2352x1568px.
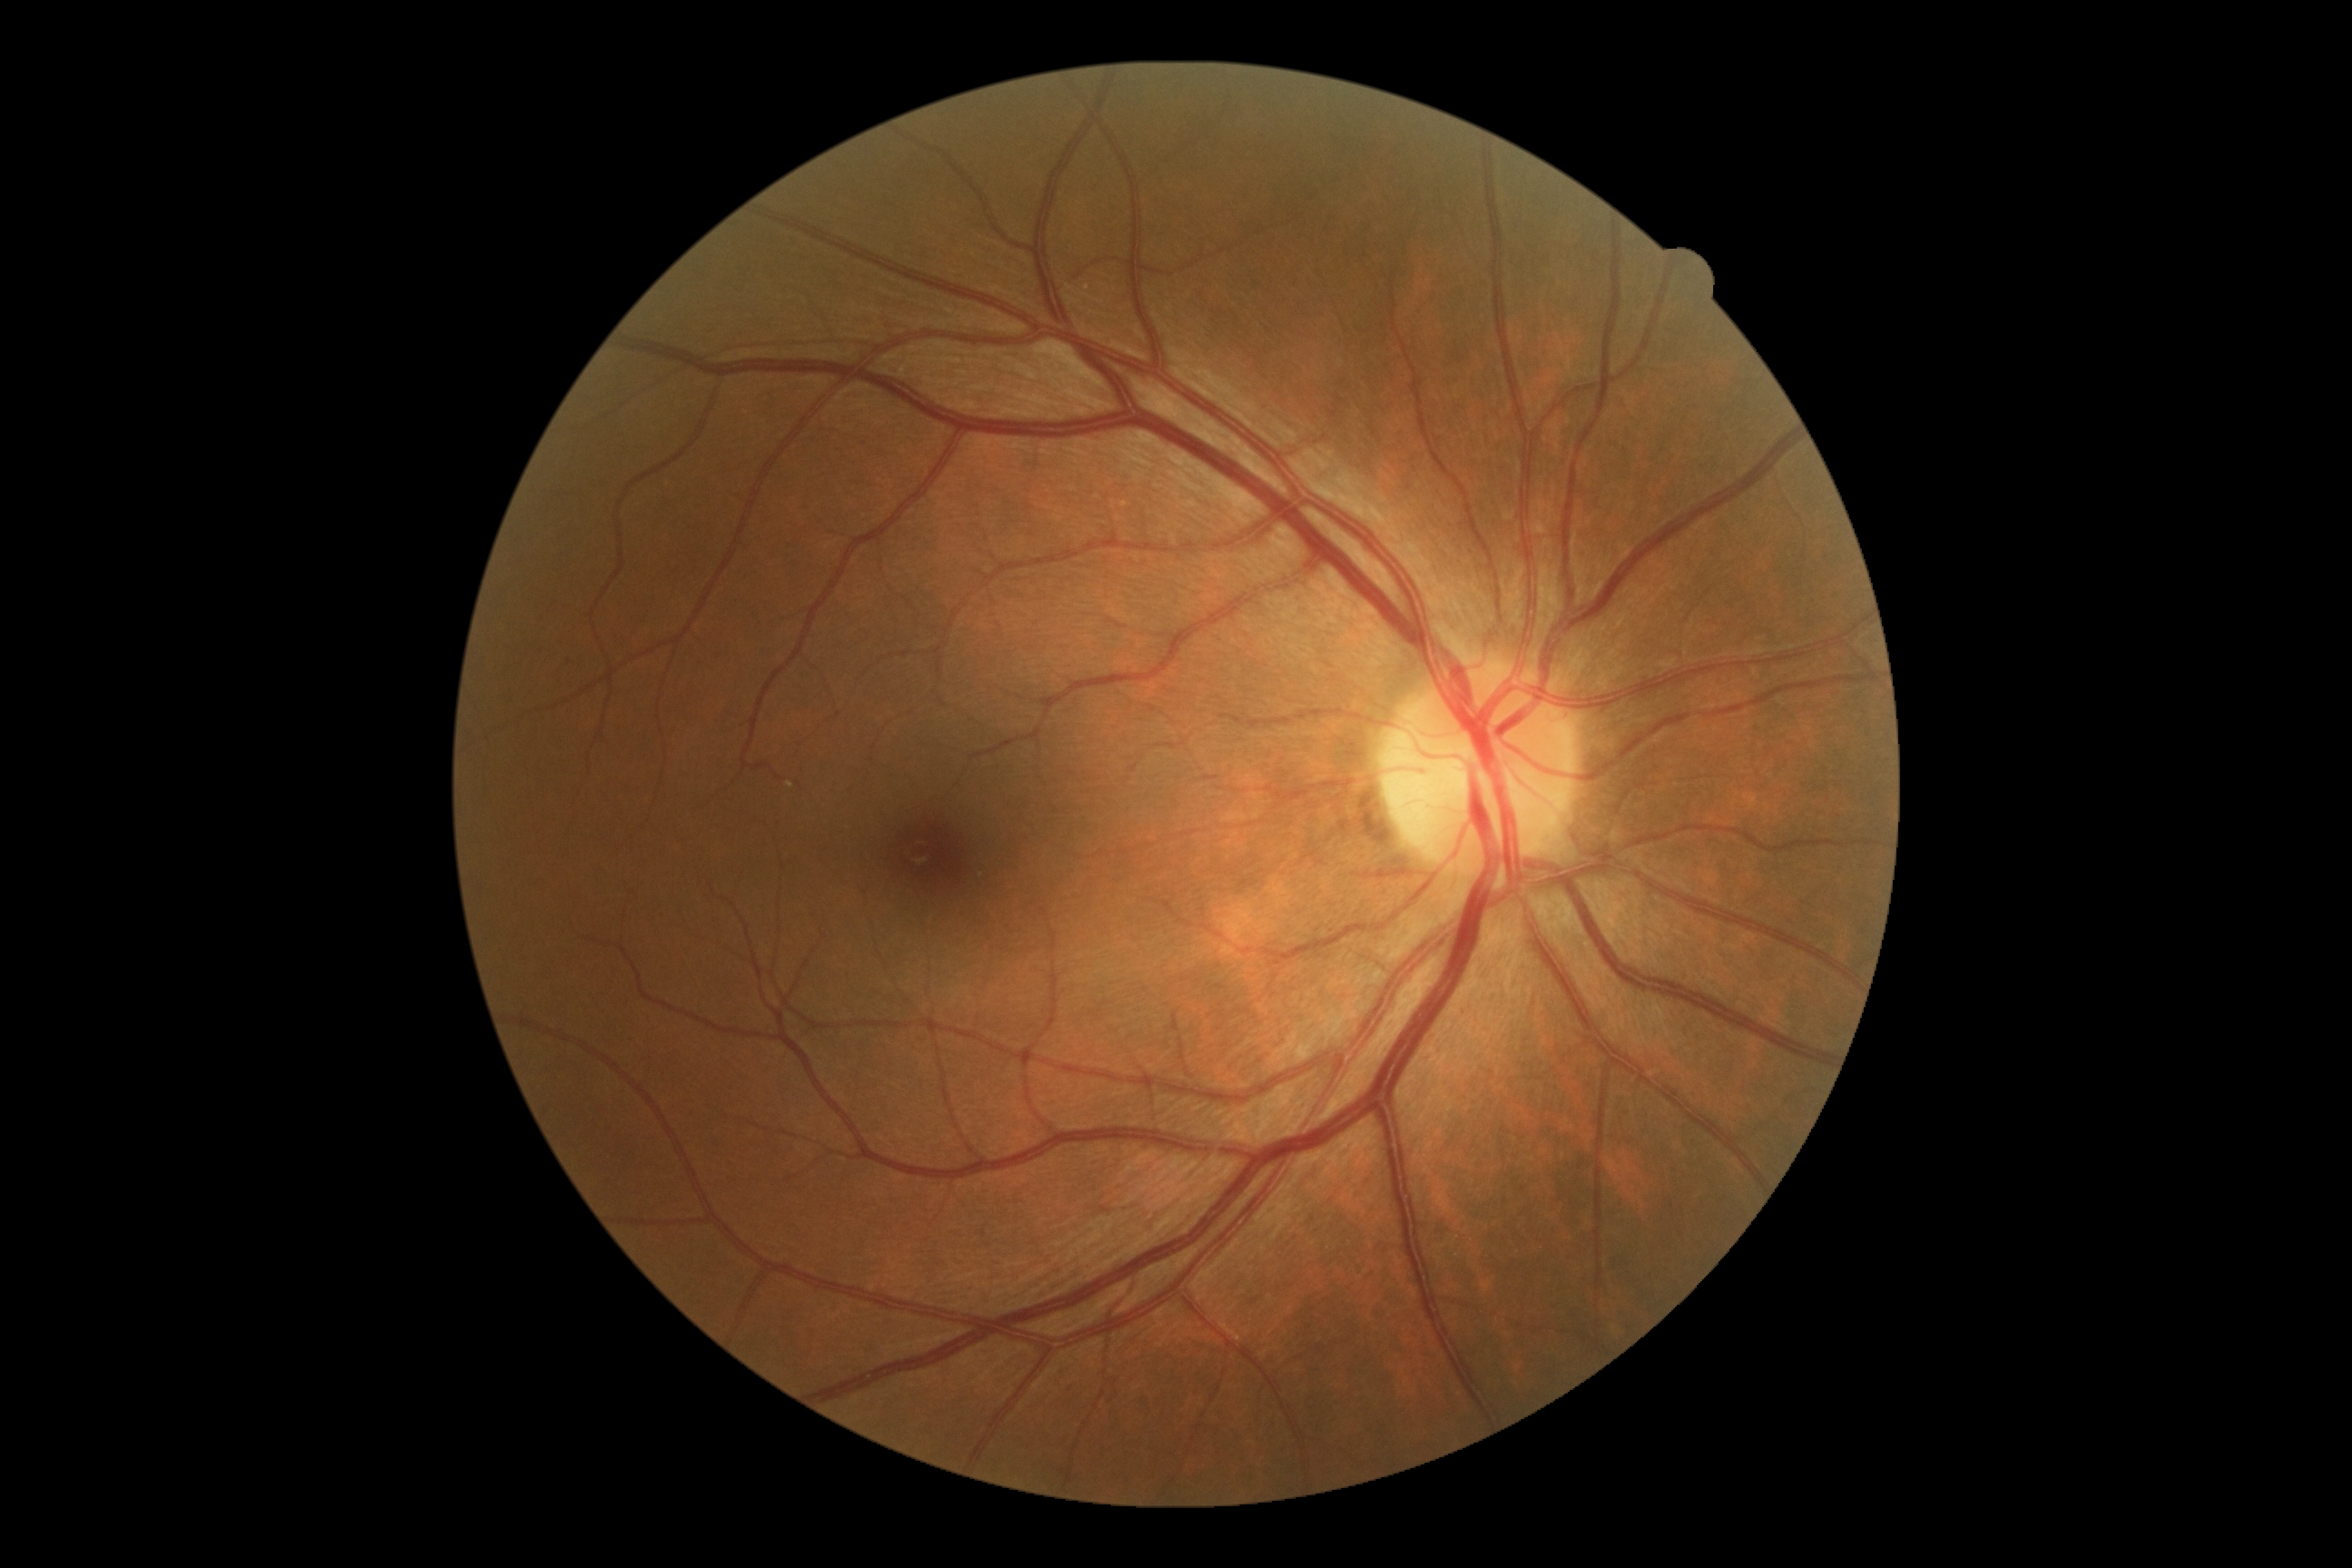 Retinopathy: 0.